Captured with the Natus RetCam Envision (130° field of view); 1440x1080; infant wide-field retinal image — 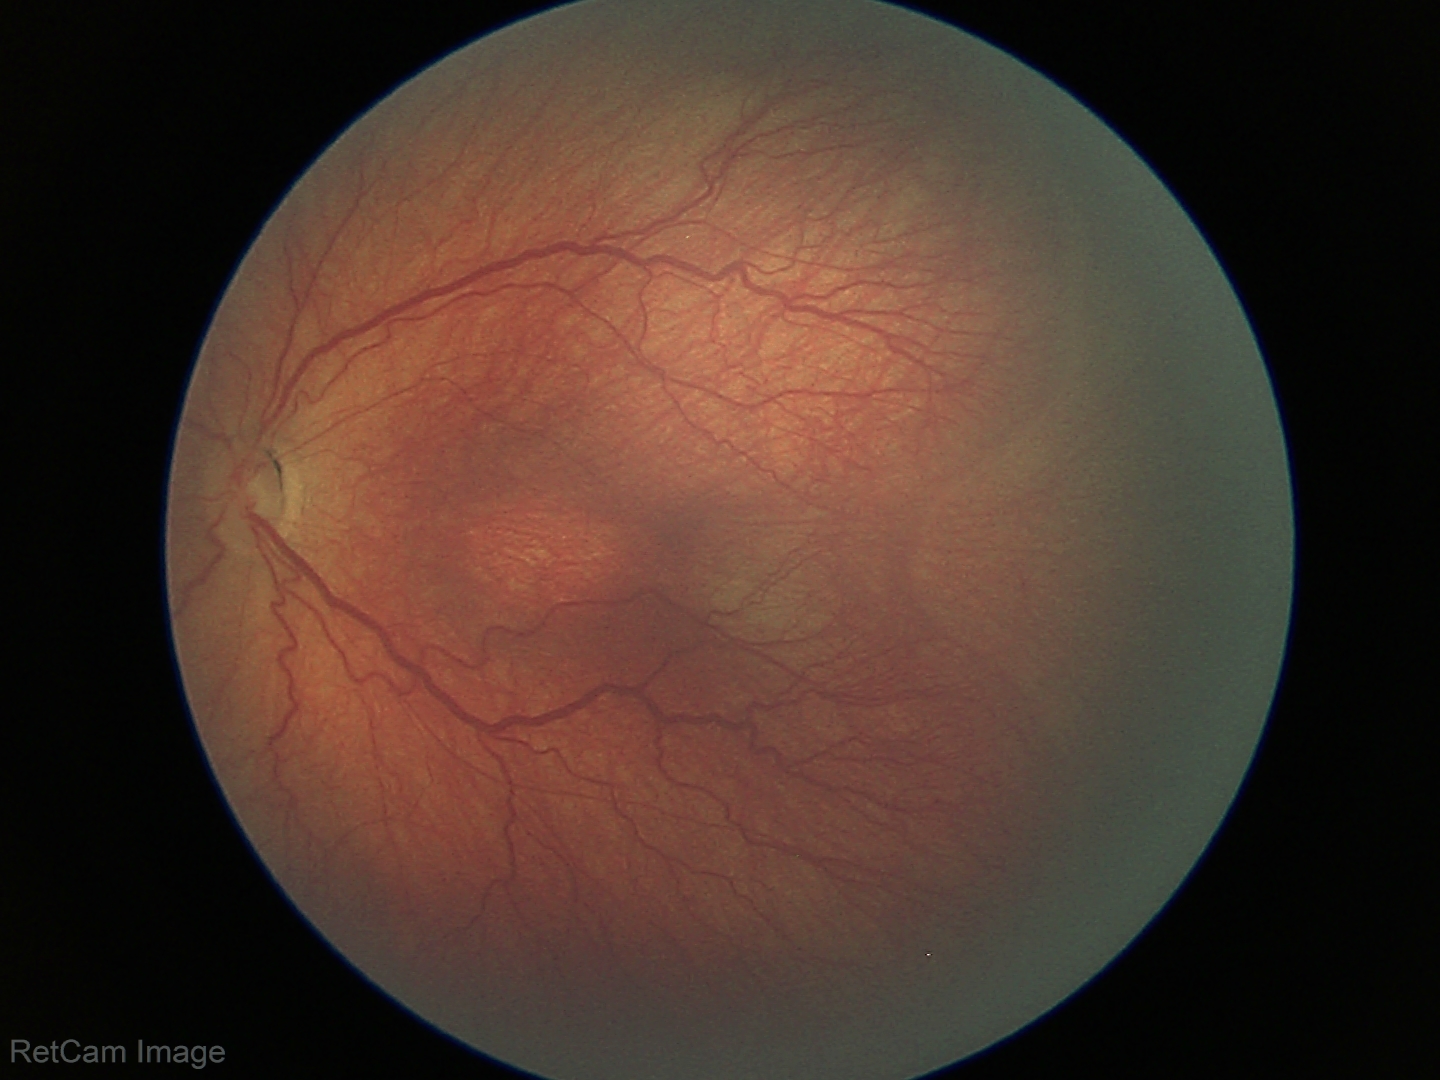 Assessment: retinopathy of prematurity (ROP) stage 3 | no plus disease — posterior pole vessels without abnormal dilation or tortuosity.